Nonmydriatic, camera: NIDEK AFC-230.
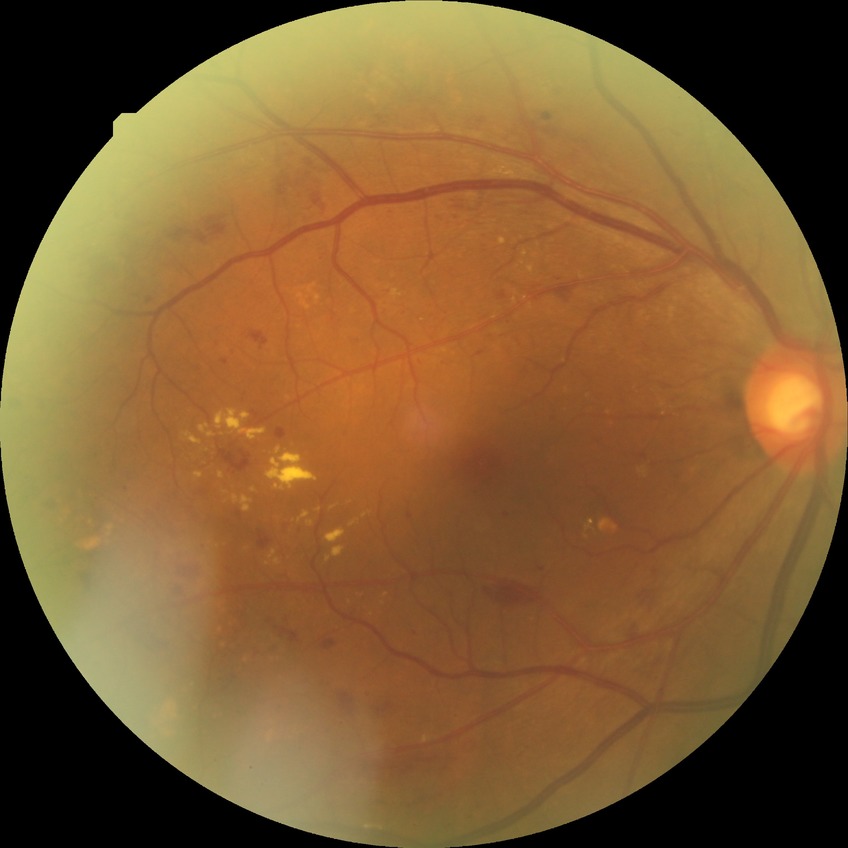

  davis_grade: PPDR (pre-proliferative diabetic retinopathy)